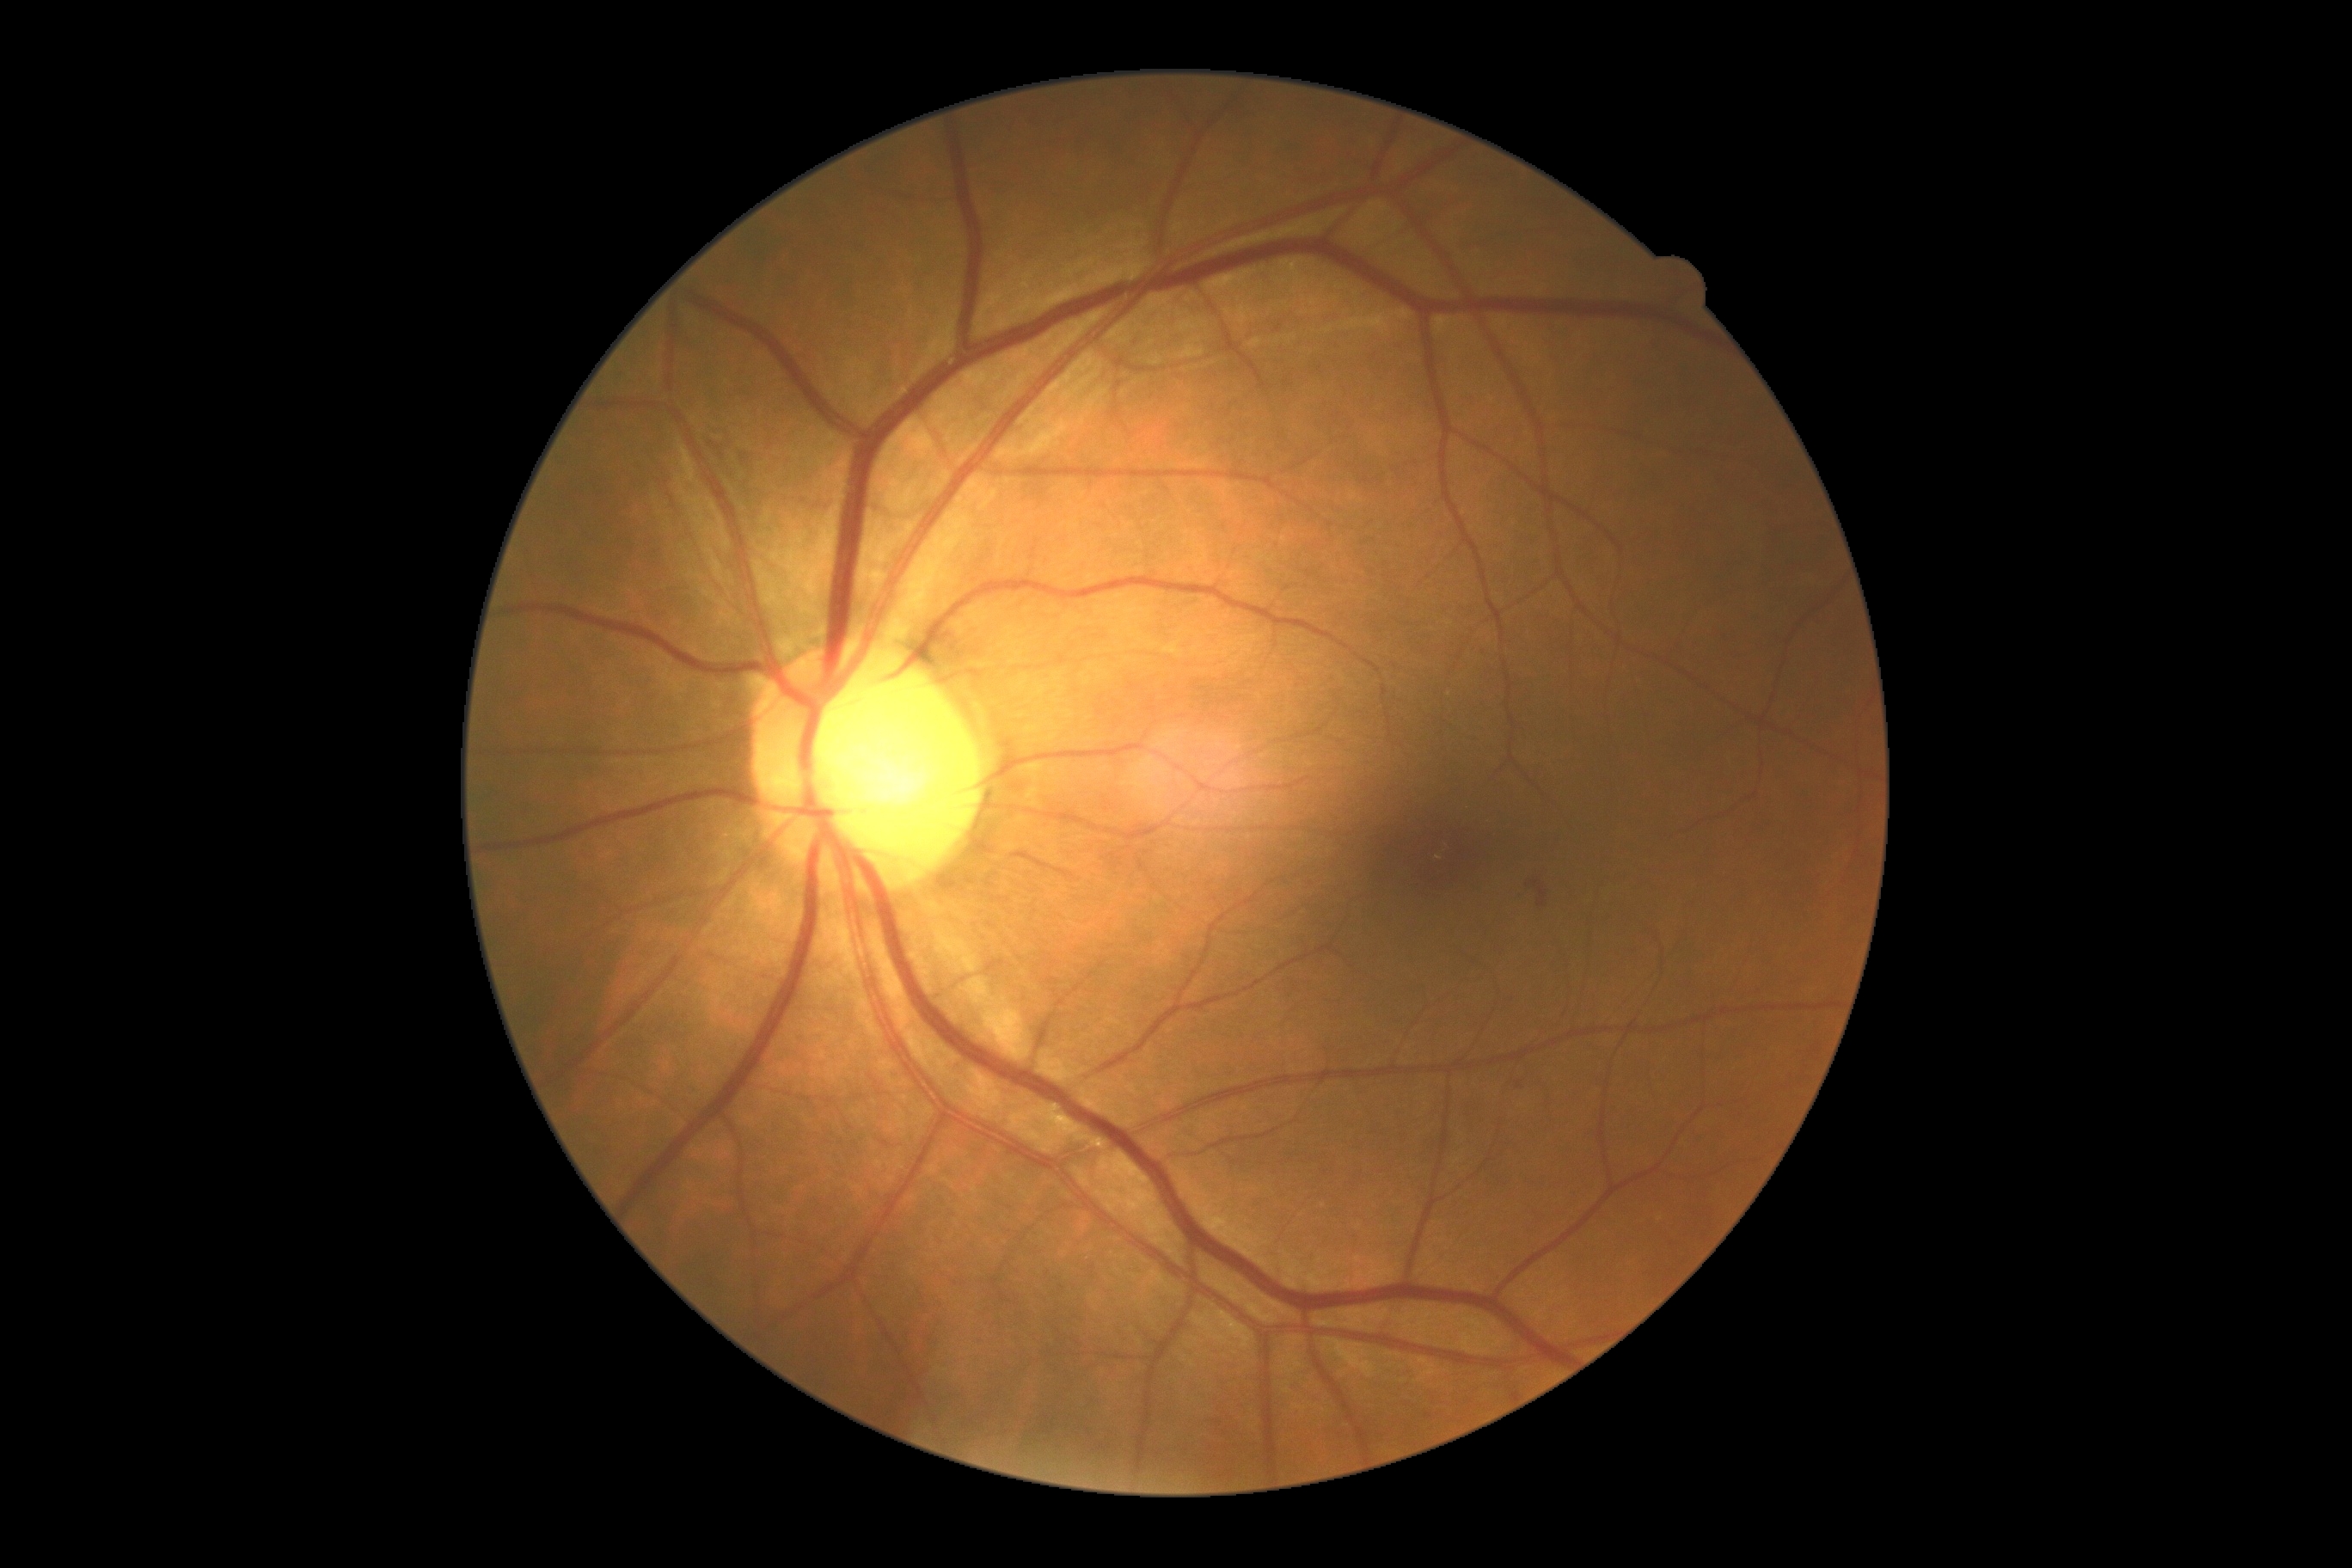 Retinopathy grade is 2 (moderate NPDR) — more than just microaneurysms but less than severe NPDR.